FOV: 200 degrees, ultra-widefield fundus photograph, 1924x1556: 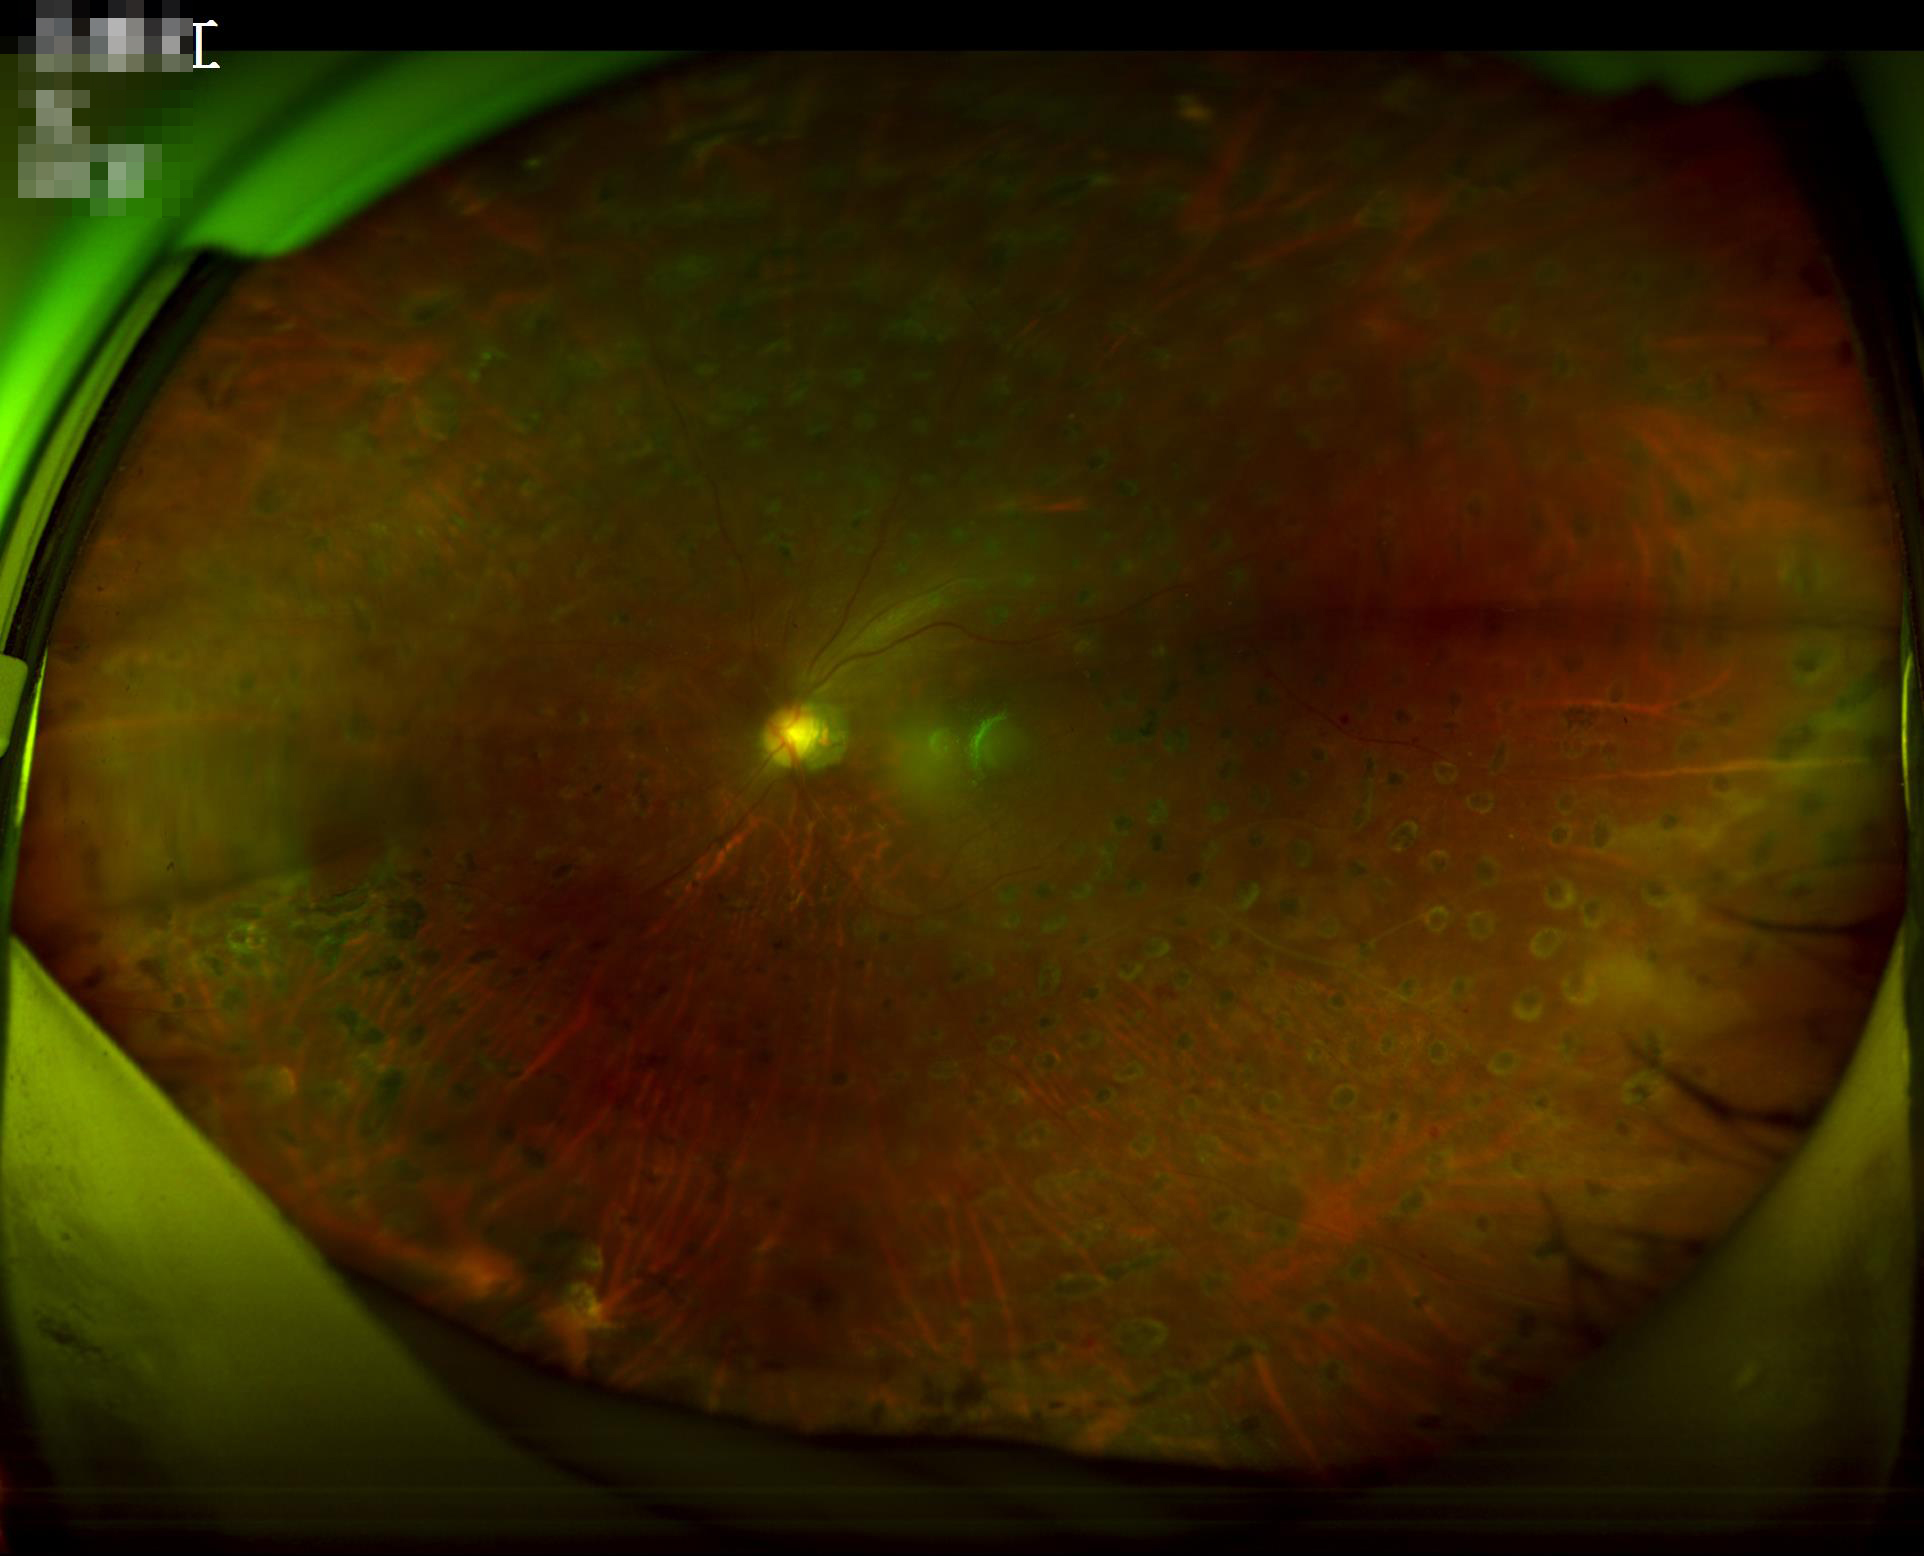
Focus = clear | Illumination = satisfactory | Overall quality = inadequate | Contrast = reduced.